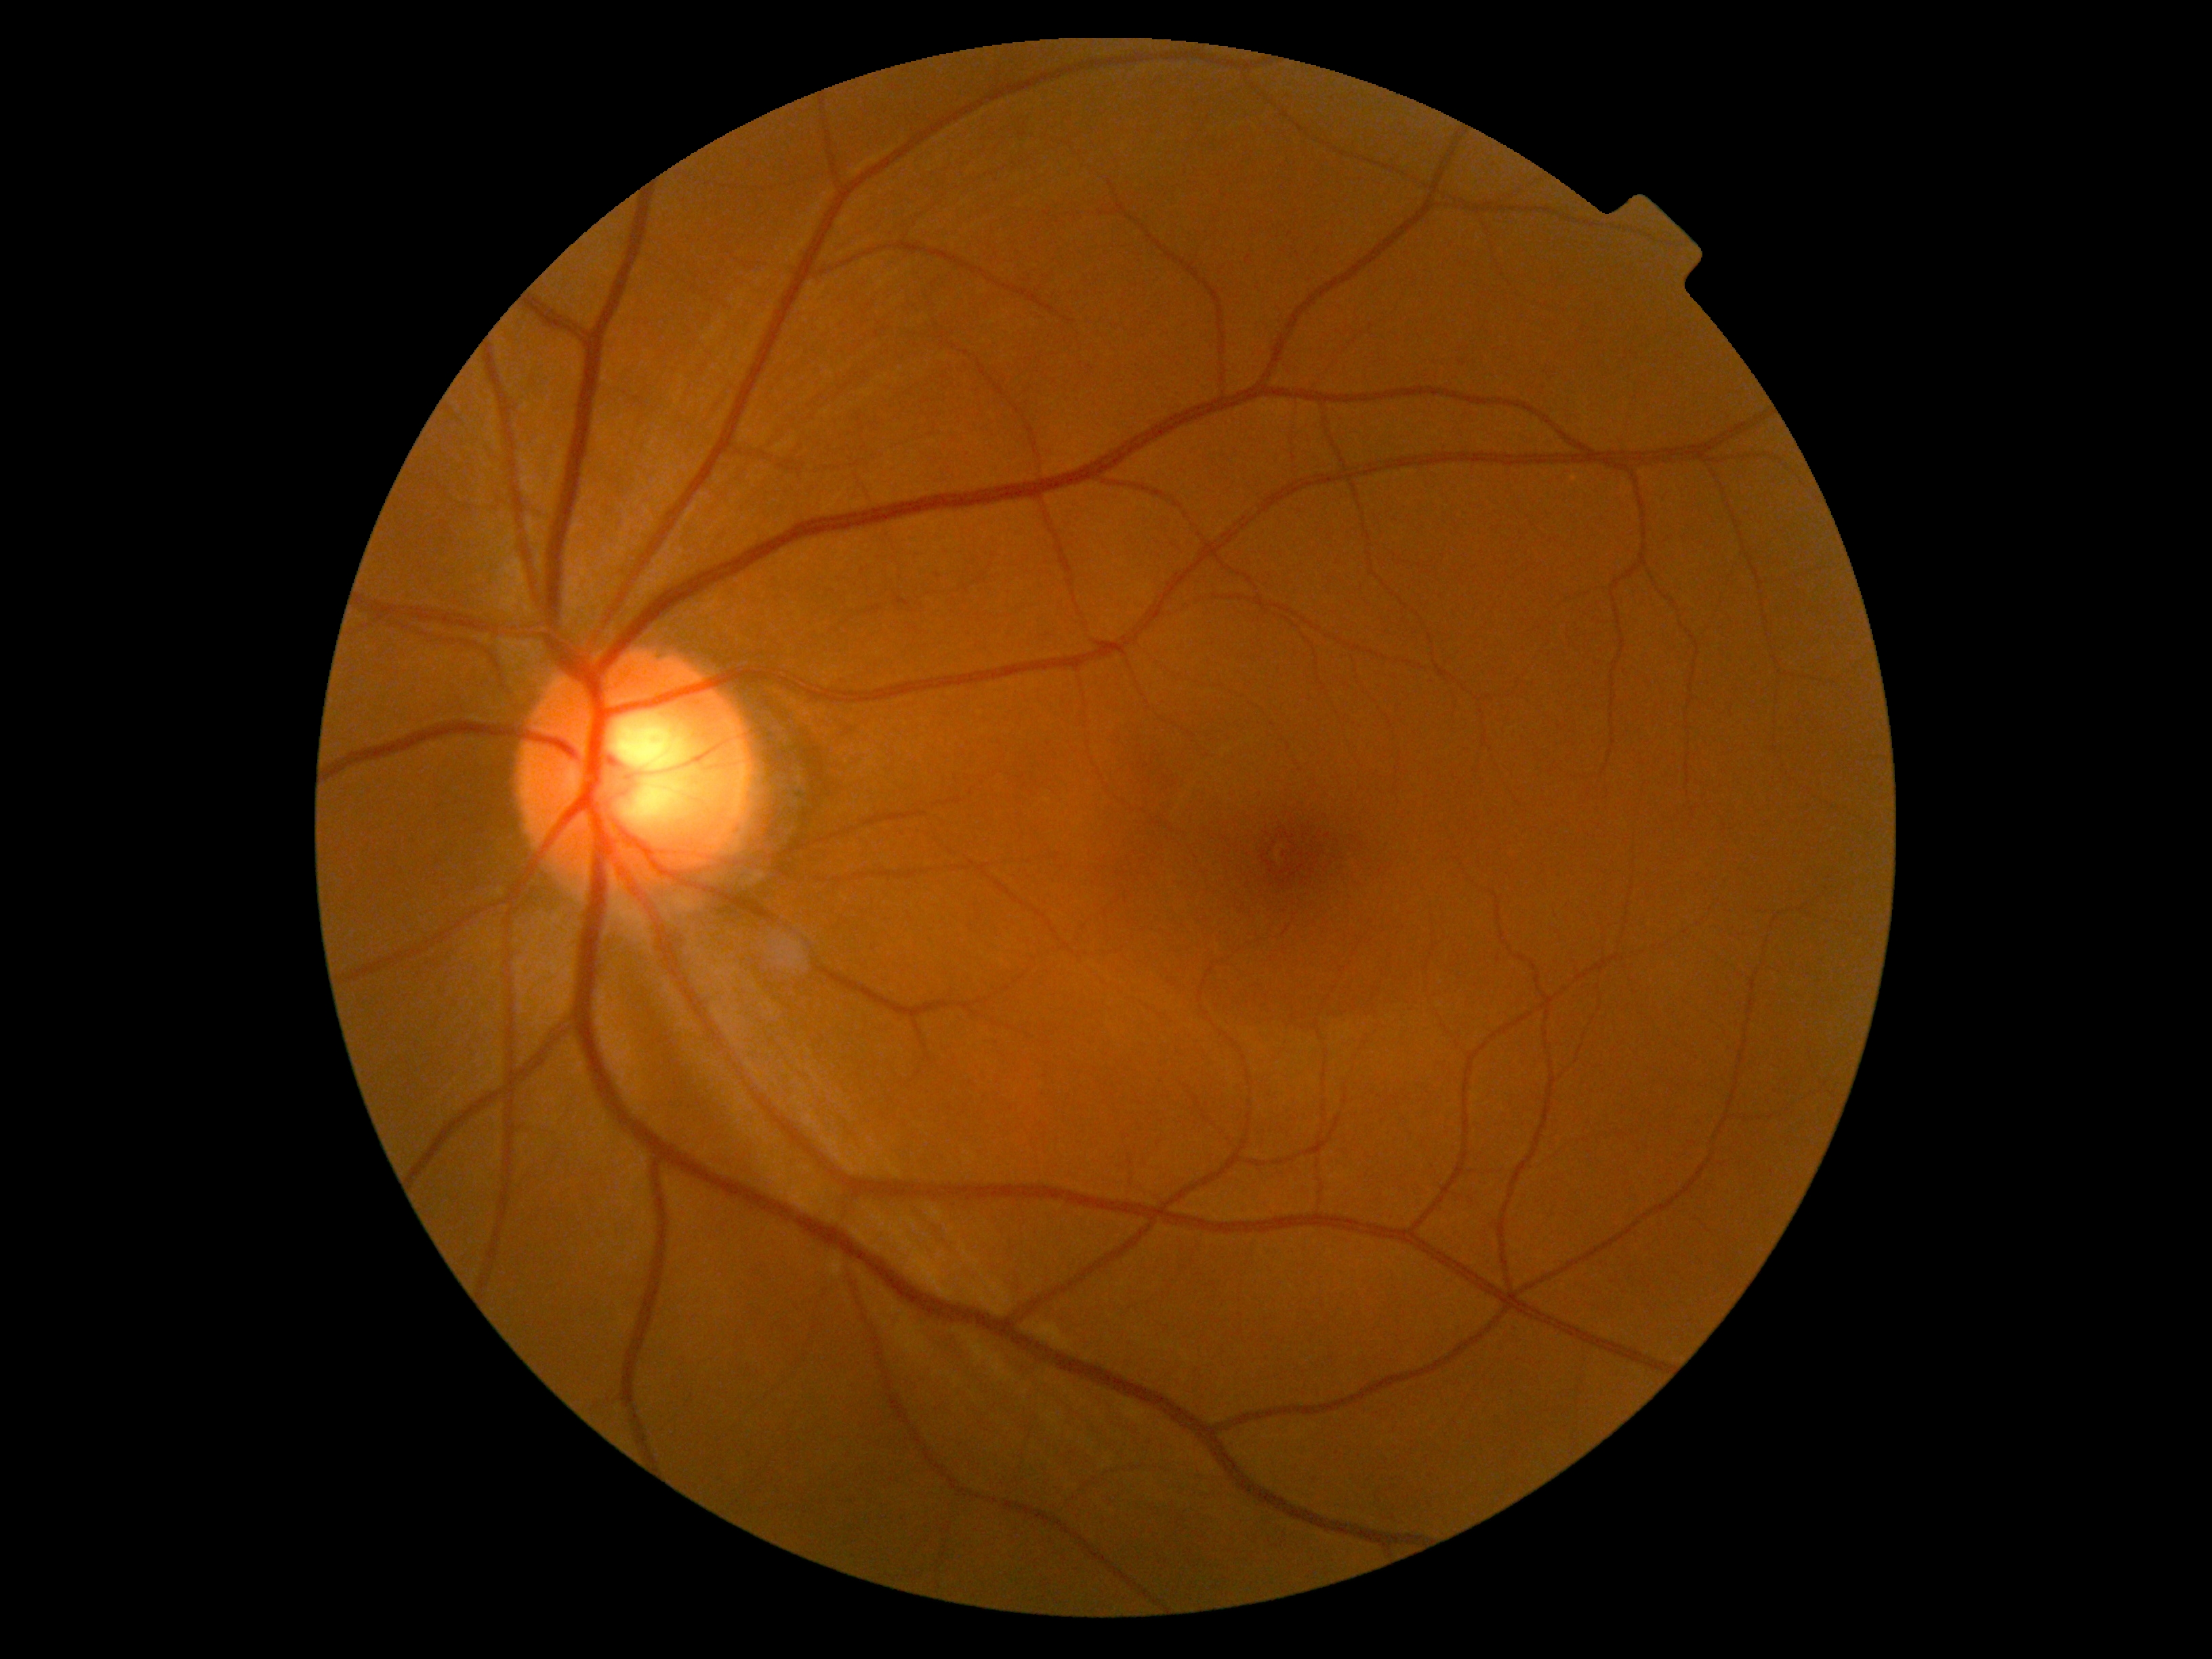
DR severity is no apparent retinopathy (grade 0) — no visible signs of diabetic retinopathy.
No signs of diabetic retinopathy.